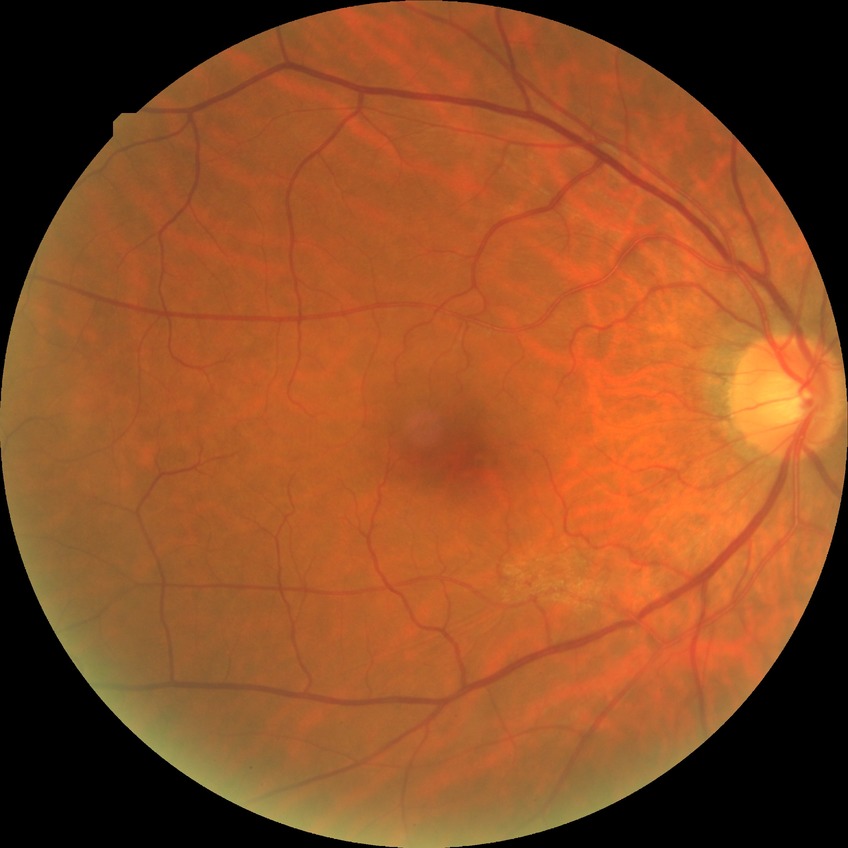 Diabetic retinopathy (DR) is no diabetic retinopathy (NDR).